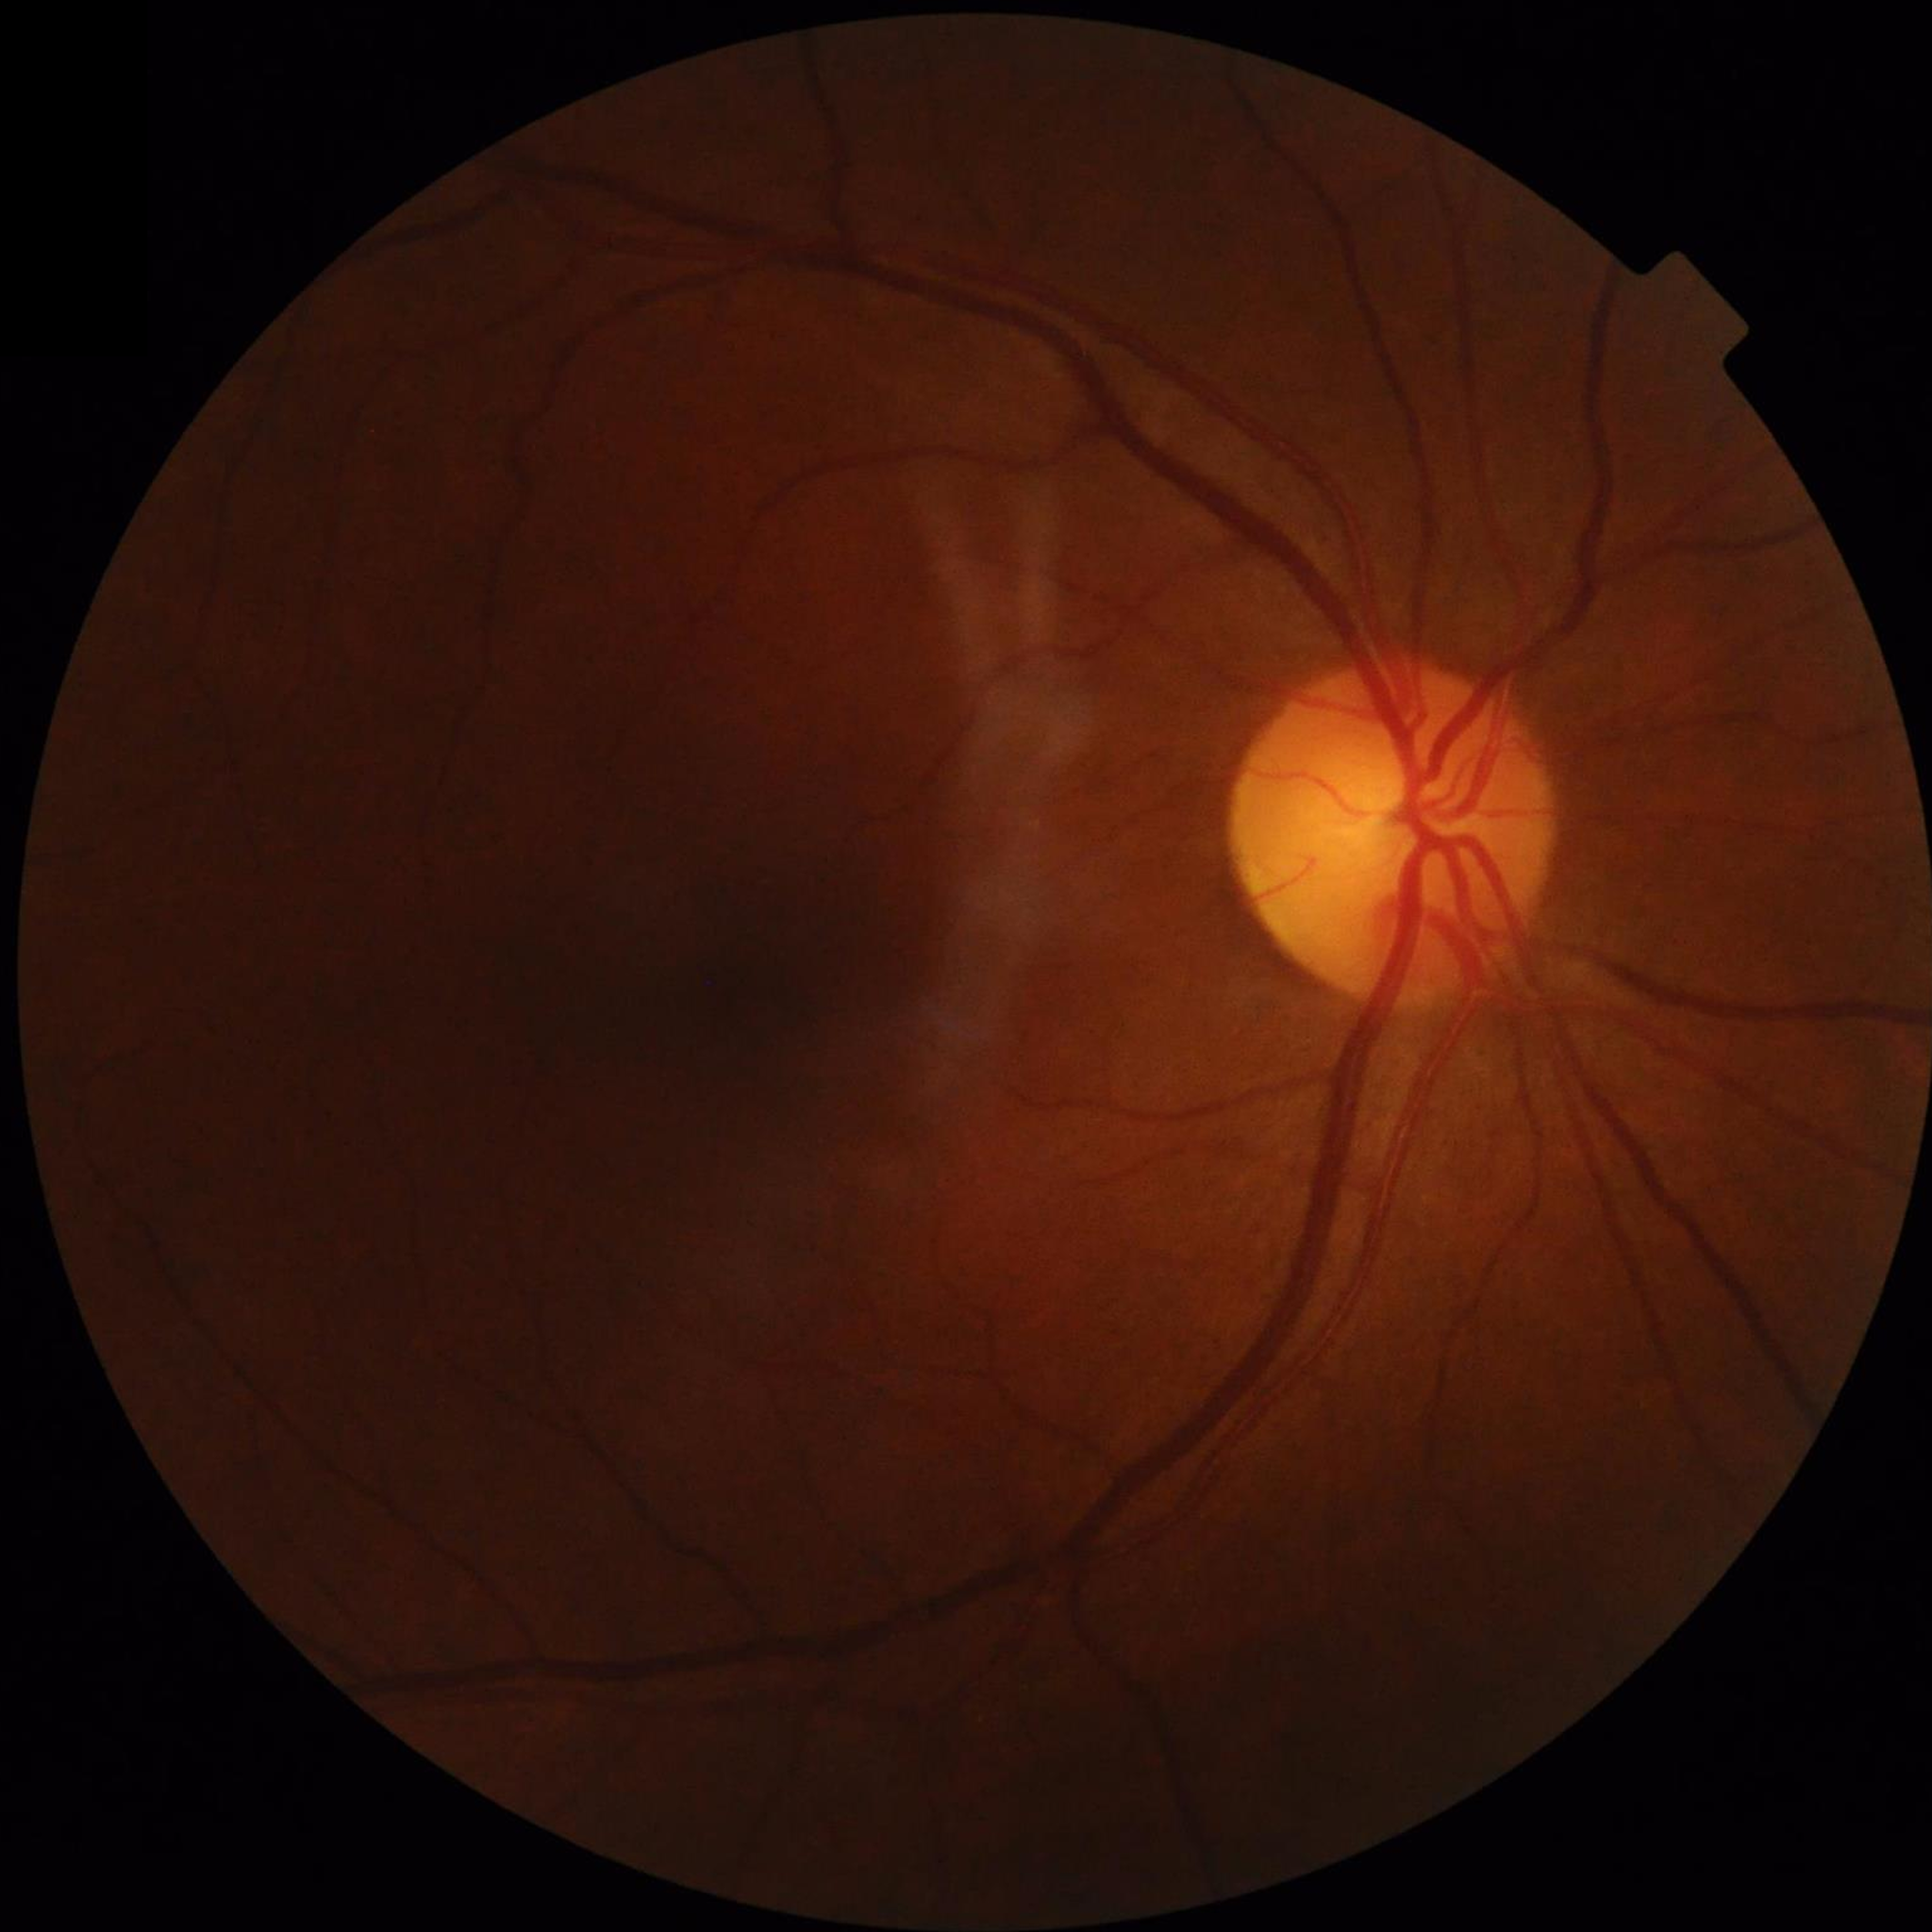

Diagnosis: no AMD, DR, or glaucomatous findings